Posterior pole color fundus photograph — 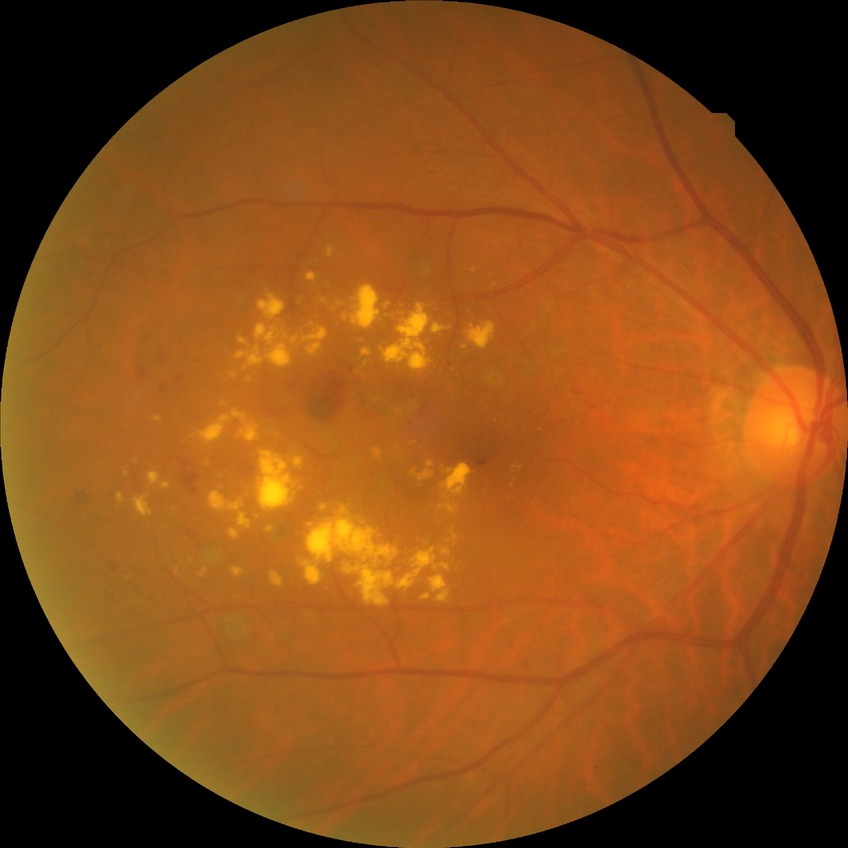 Retinopathy grade: simple diabetic retinopathy.